NIDEK AFC-230 fundus camera. 45 degree fundus photograph. Posterior pole photograph. Nonmydriatic fundus photograph. 848x848px. Davis DR grading:
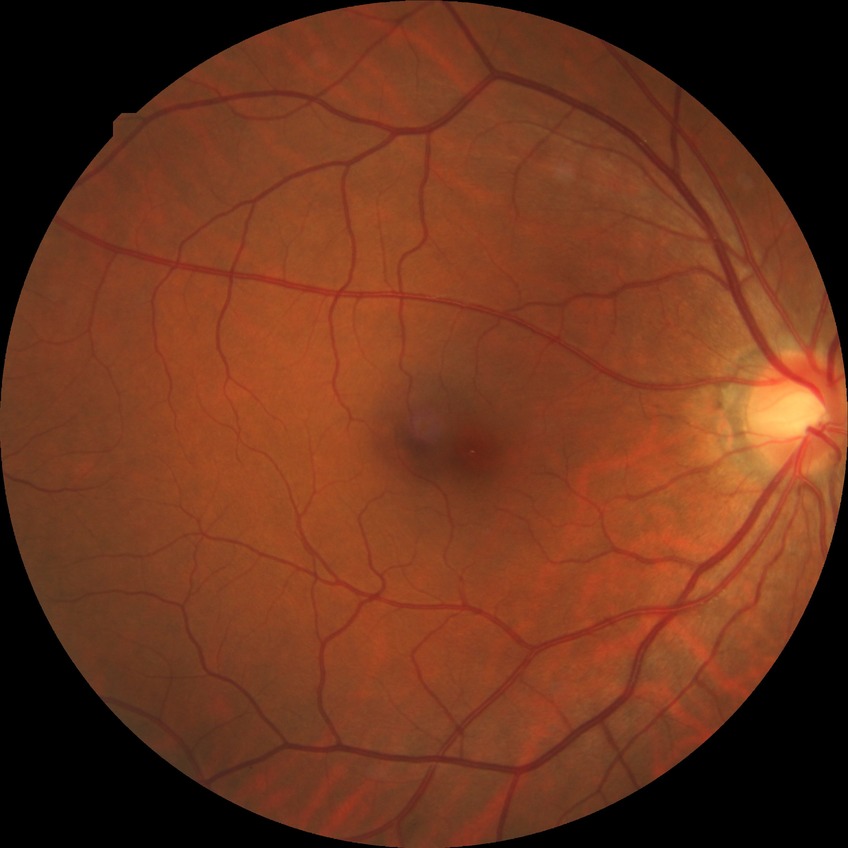
Davis grading: no diabetic retinopathy.